2048 x 1536 pixels — 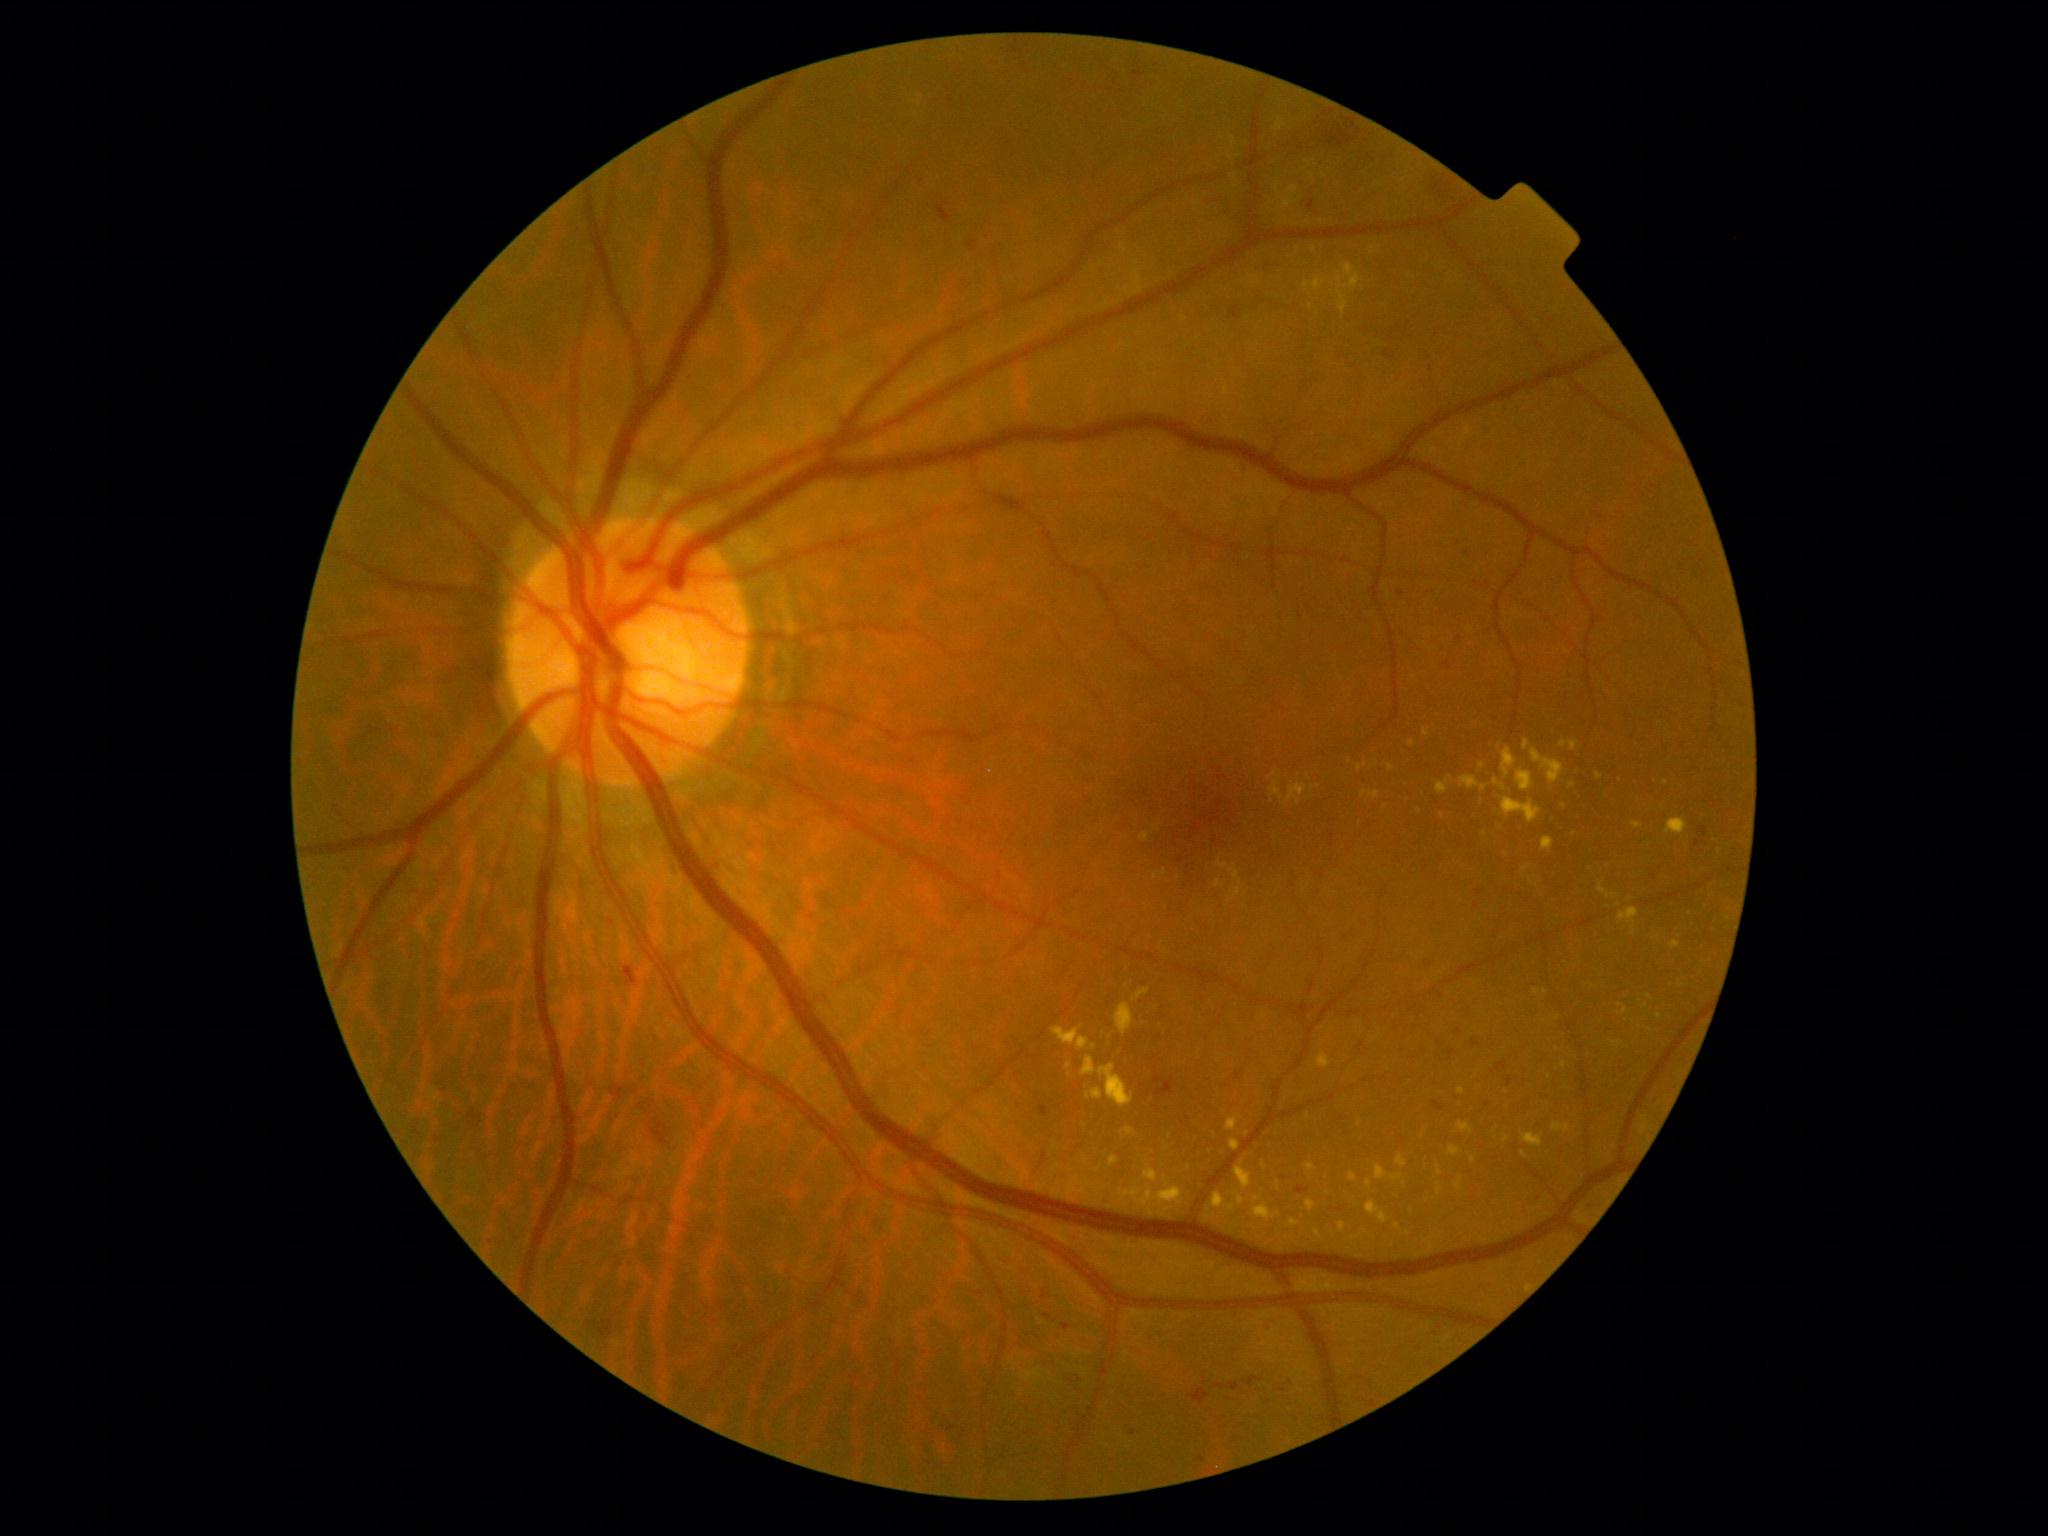 Retinopathy is grade 2.
Hard exudates include those at [1493, 779, 1506, 792] | [1109, 1156, 1120, 1168] | [1122, 1129, 1135, 1136] | [1086, 1089, 1103, 1102] | [1423, 729, 1431, 737] | [1457, 1122, 1473, 1135] | [1459, 776, 1489, 792] | [1596, 773, 1604, 780] | [1571, 742, 1579, 752] | [1337, 264, 1361, 314] | [1436, 776, 1452, 795] | [1397, 1156, 1407, 1168] | [1212, 1192, 1236, 1217].
Small hard exudates approximately at 1550, 1077 | 1507, 1138 | 1264, 1167 | 1525, 1155 | 1365, 766 | 1247, 1135.